Wide-field fundus photograph from neonatal ROP screening — 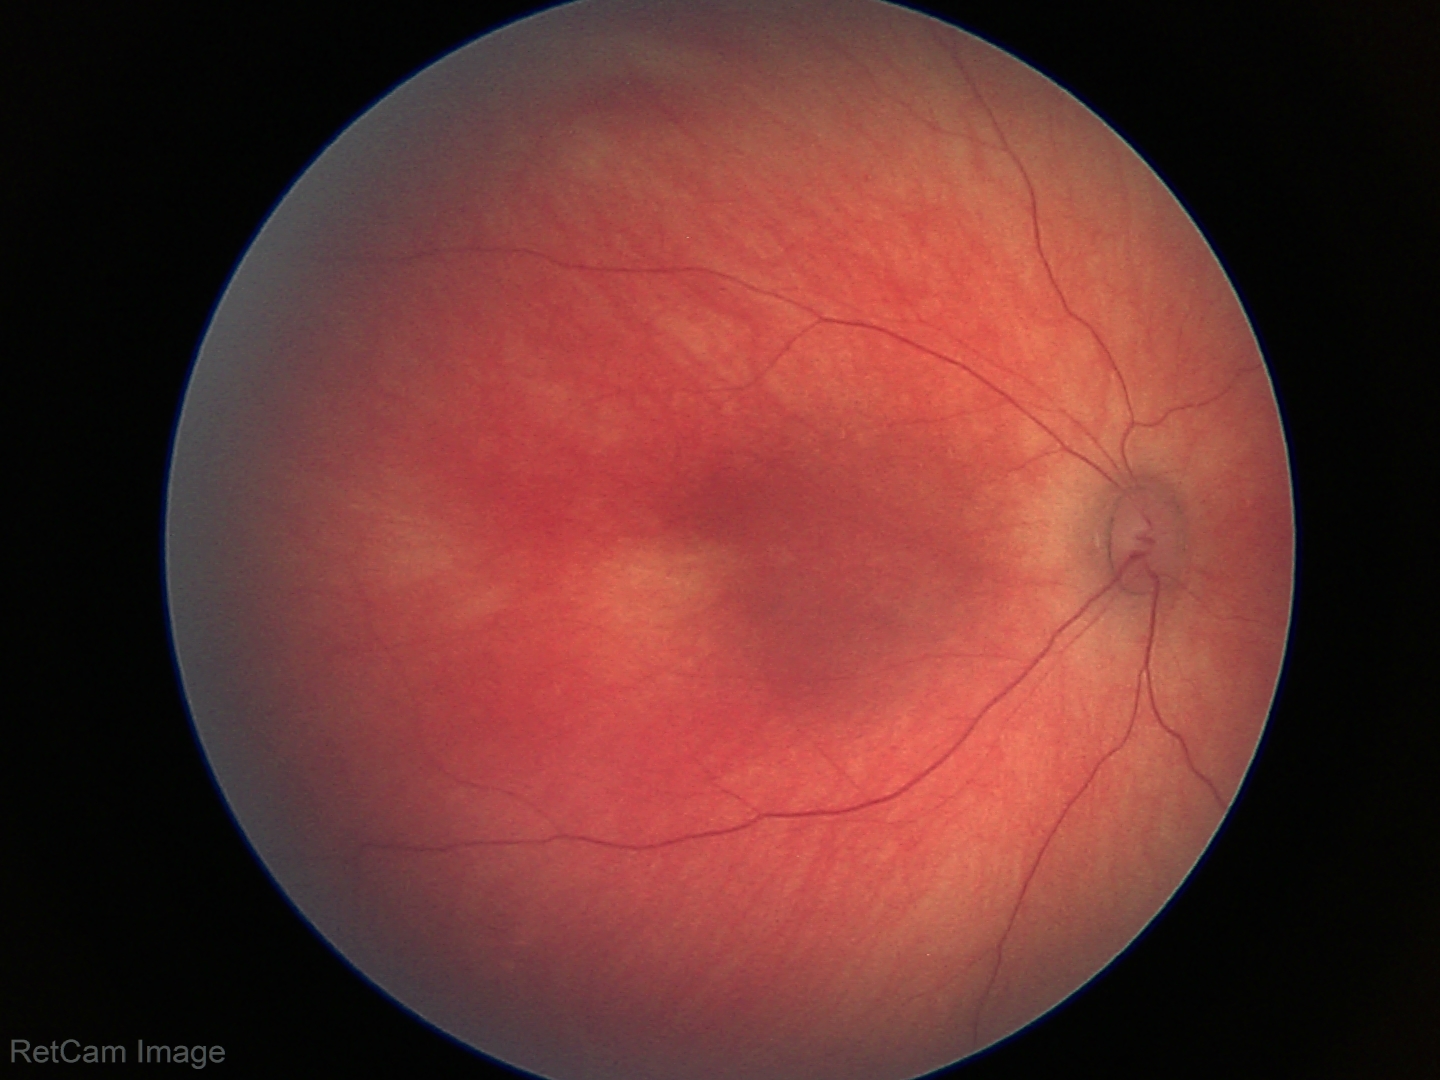
Examination with physiological retinal findings.